Acquired with a Canon CR-1, color fundus image, 2352 x 1568 pixels — 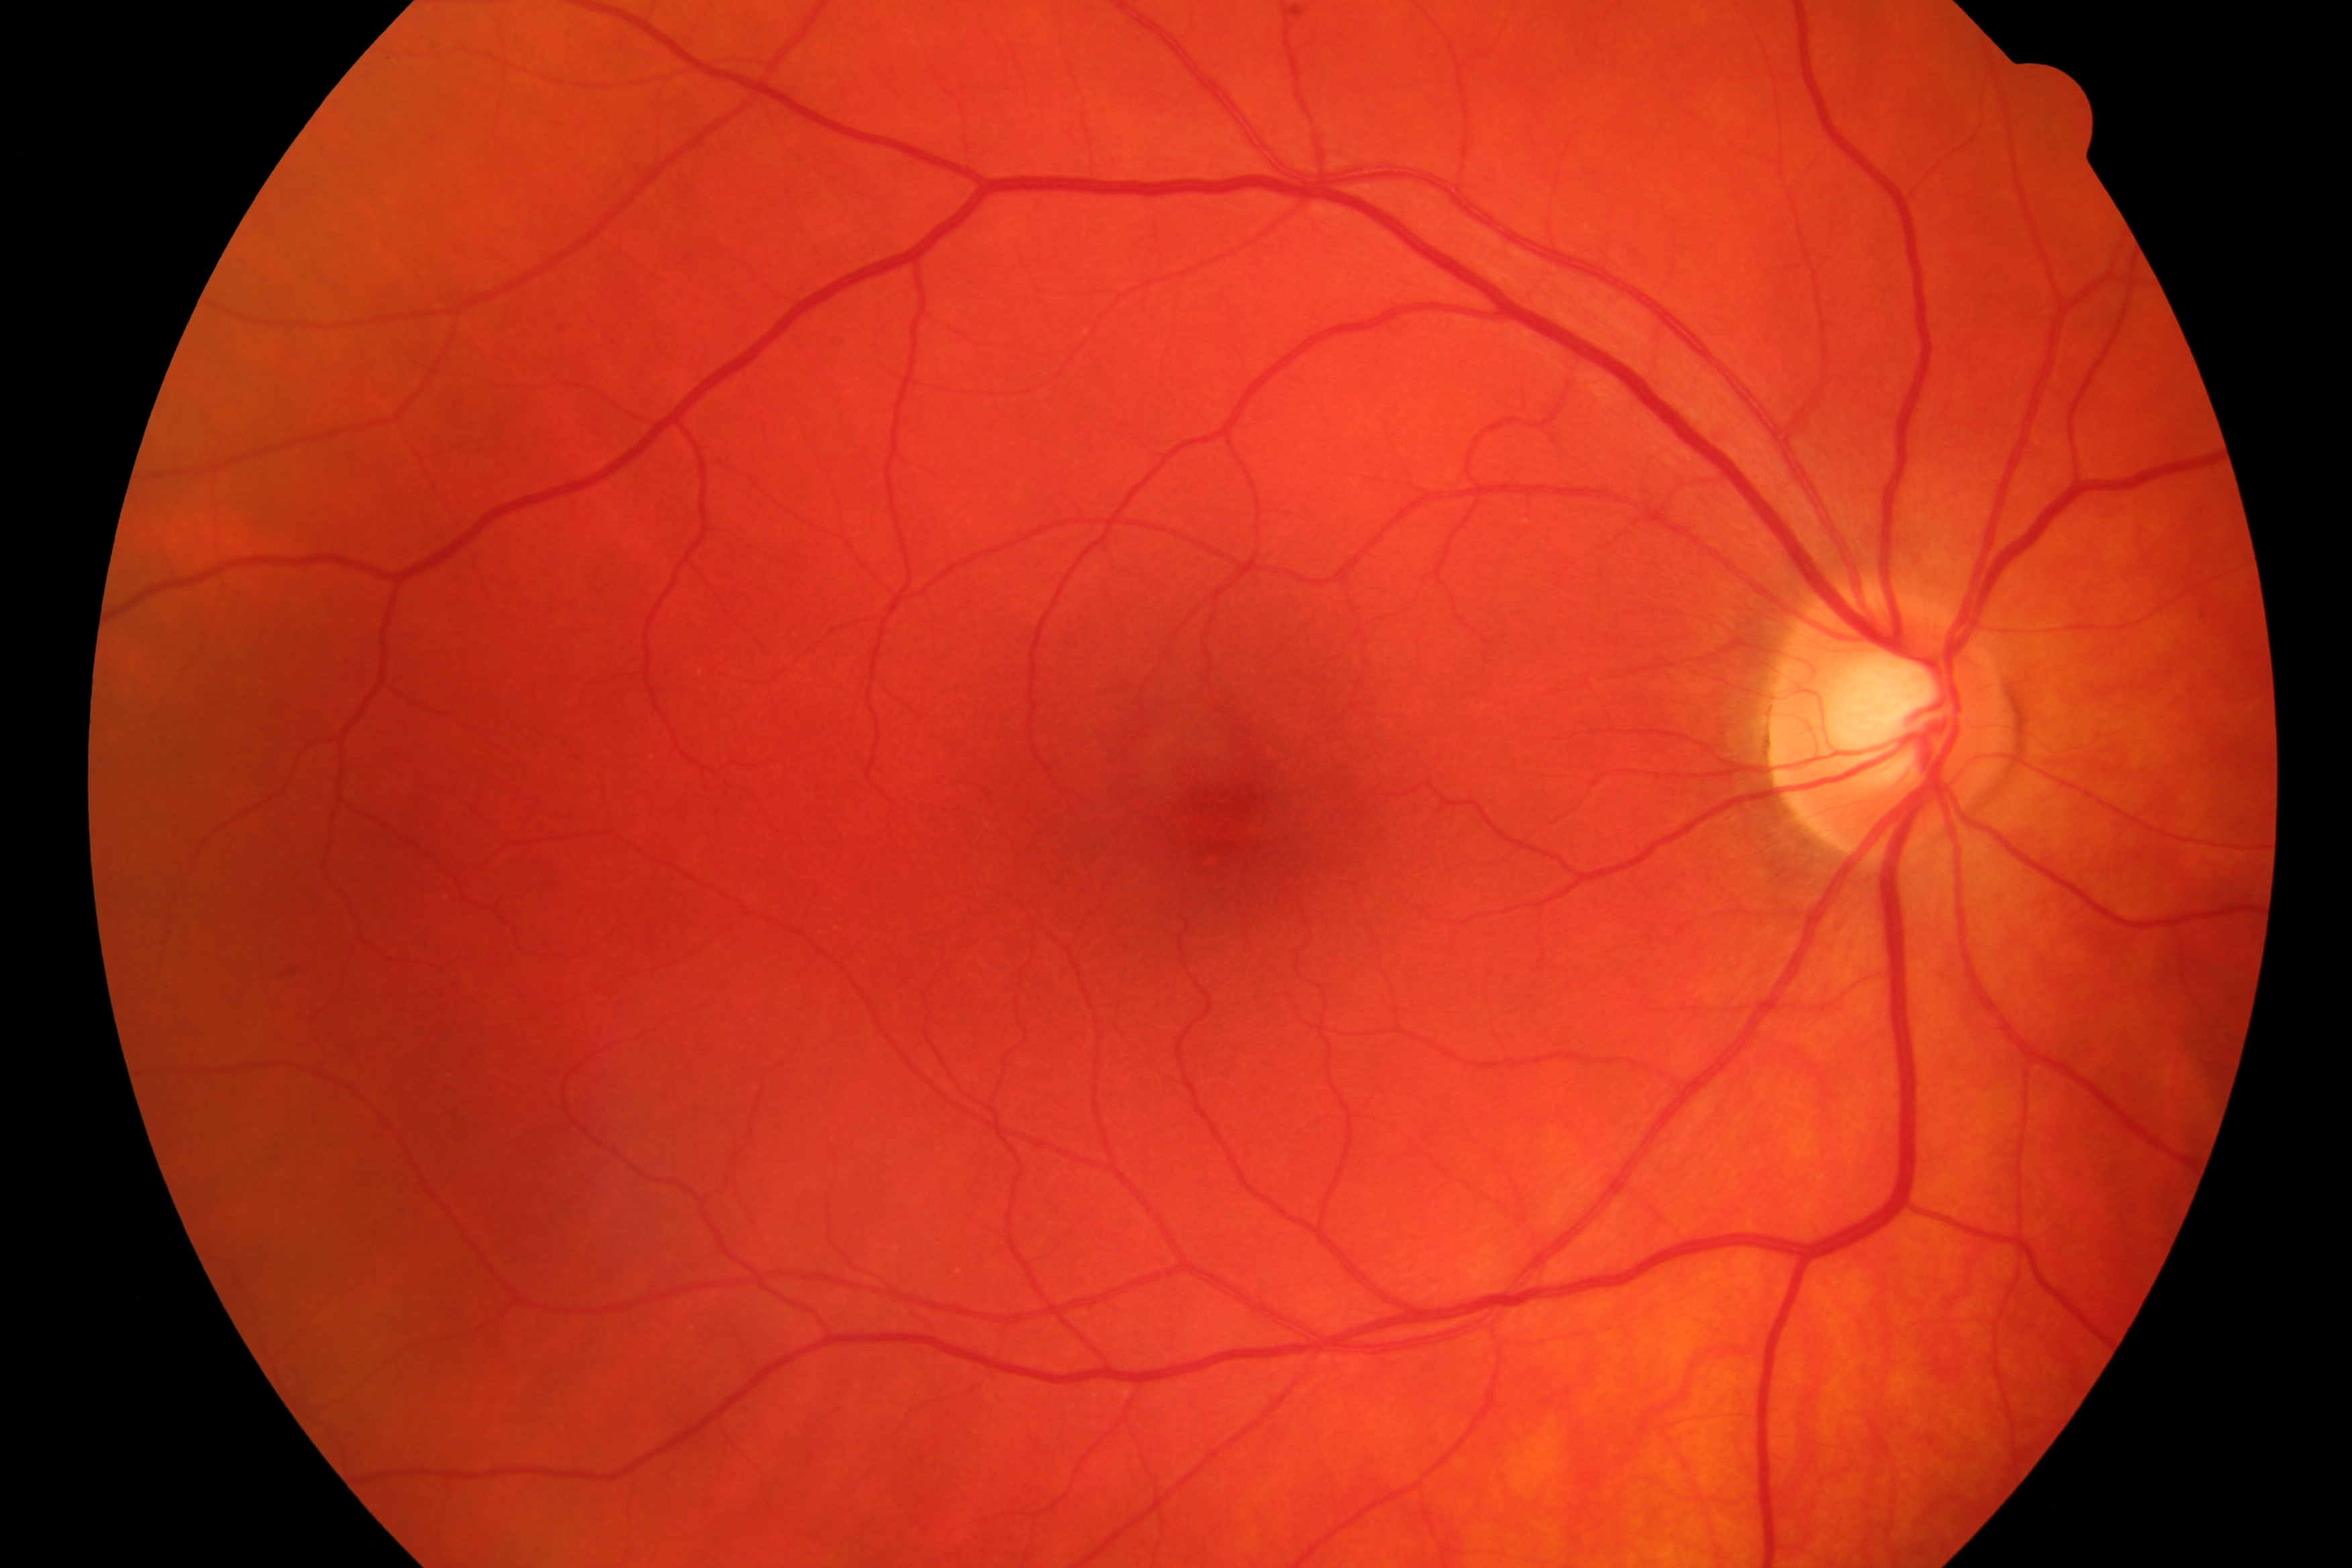 Findings: no evidence of diabetic retinopathy or glaucoma.